130° field of view (Clarity RetCam 3); image size 640x480; infant wide-field fundus photograph.
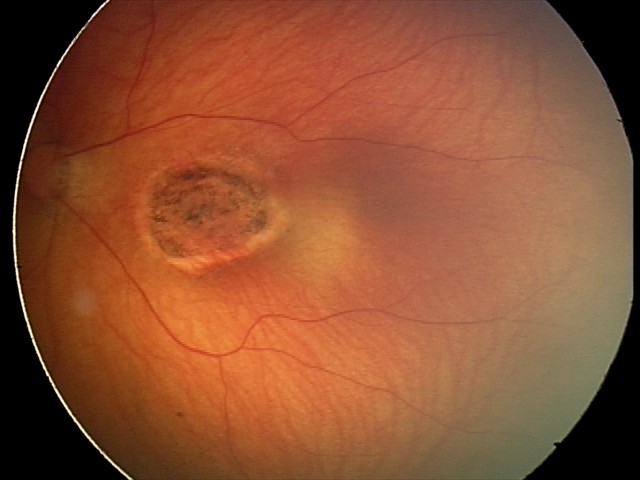 Impression: toxoplasmosis chorioretinitis.